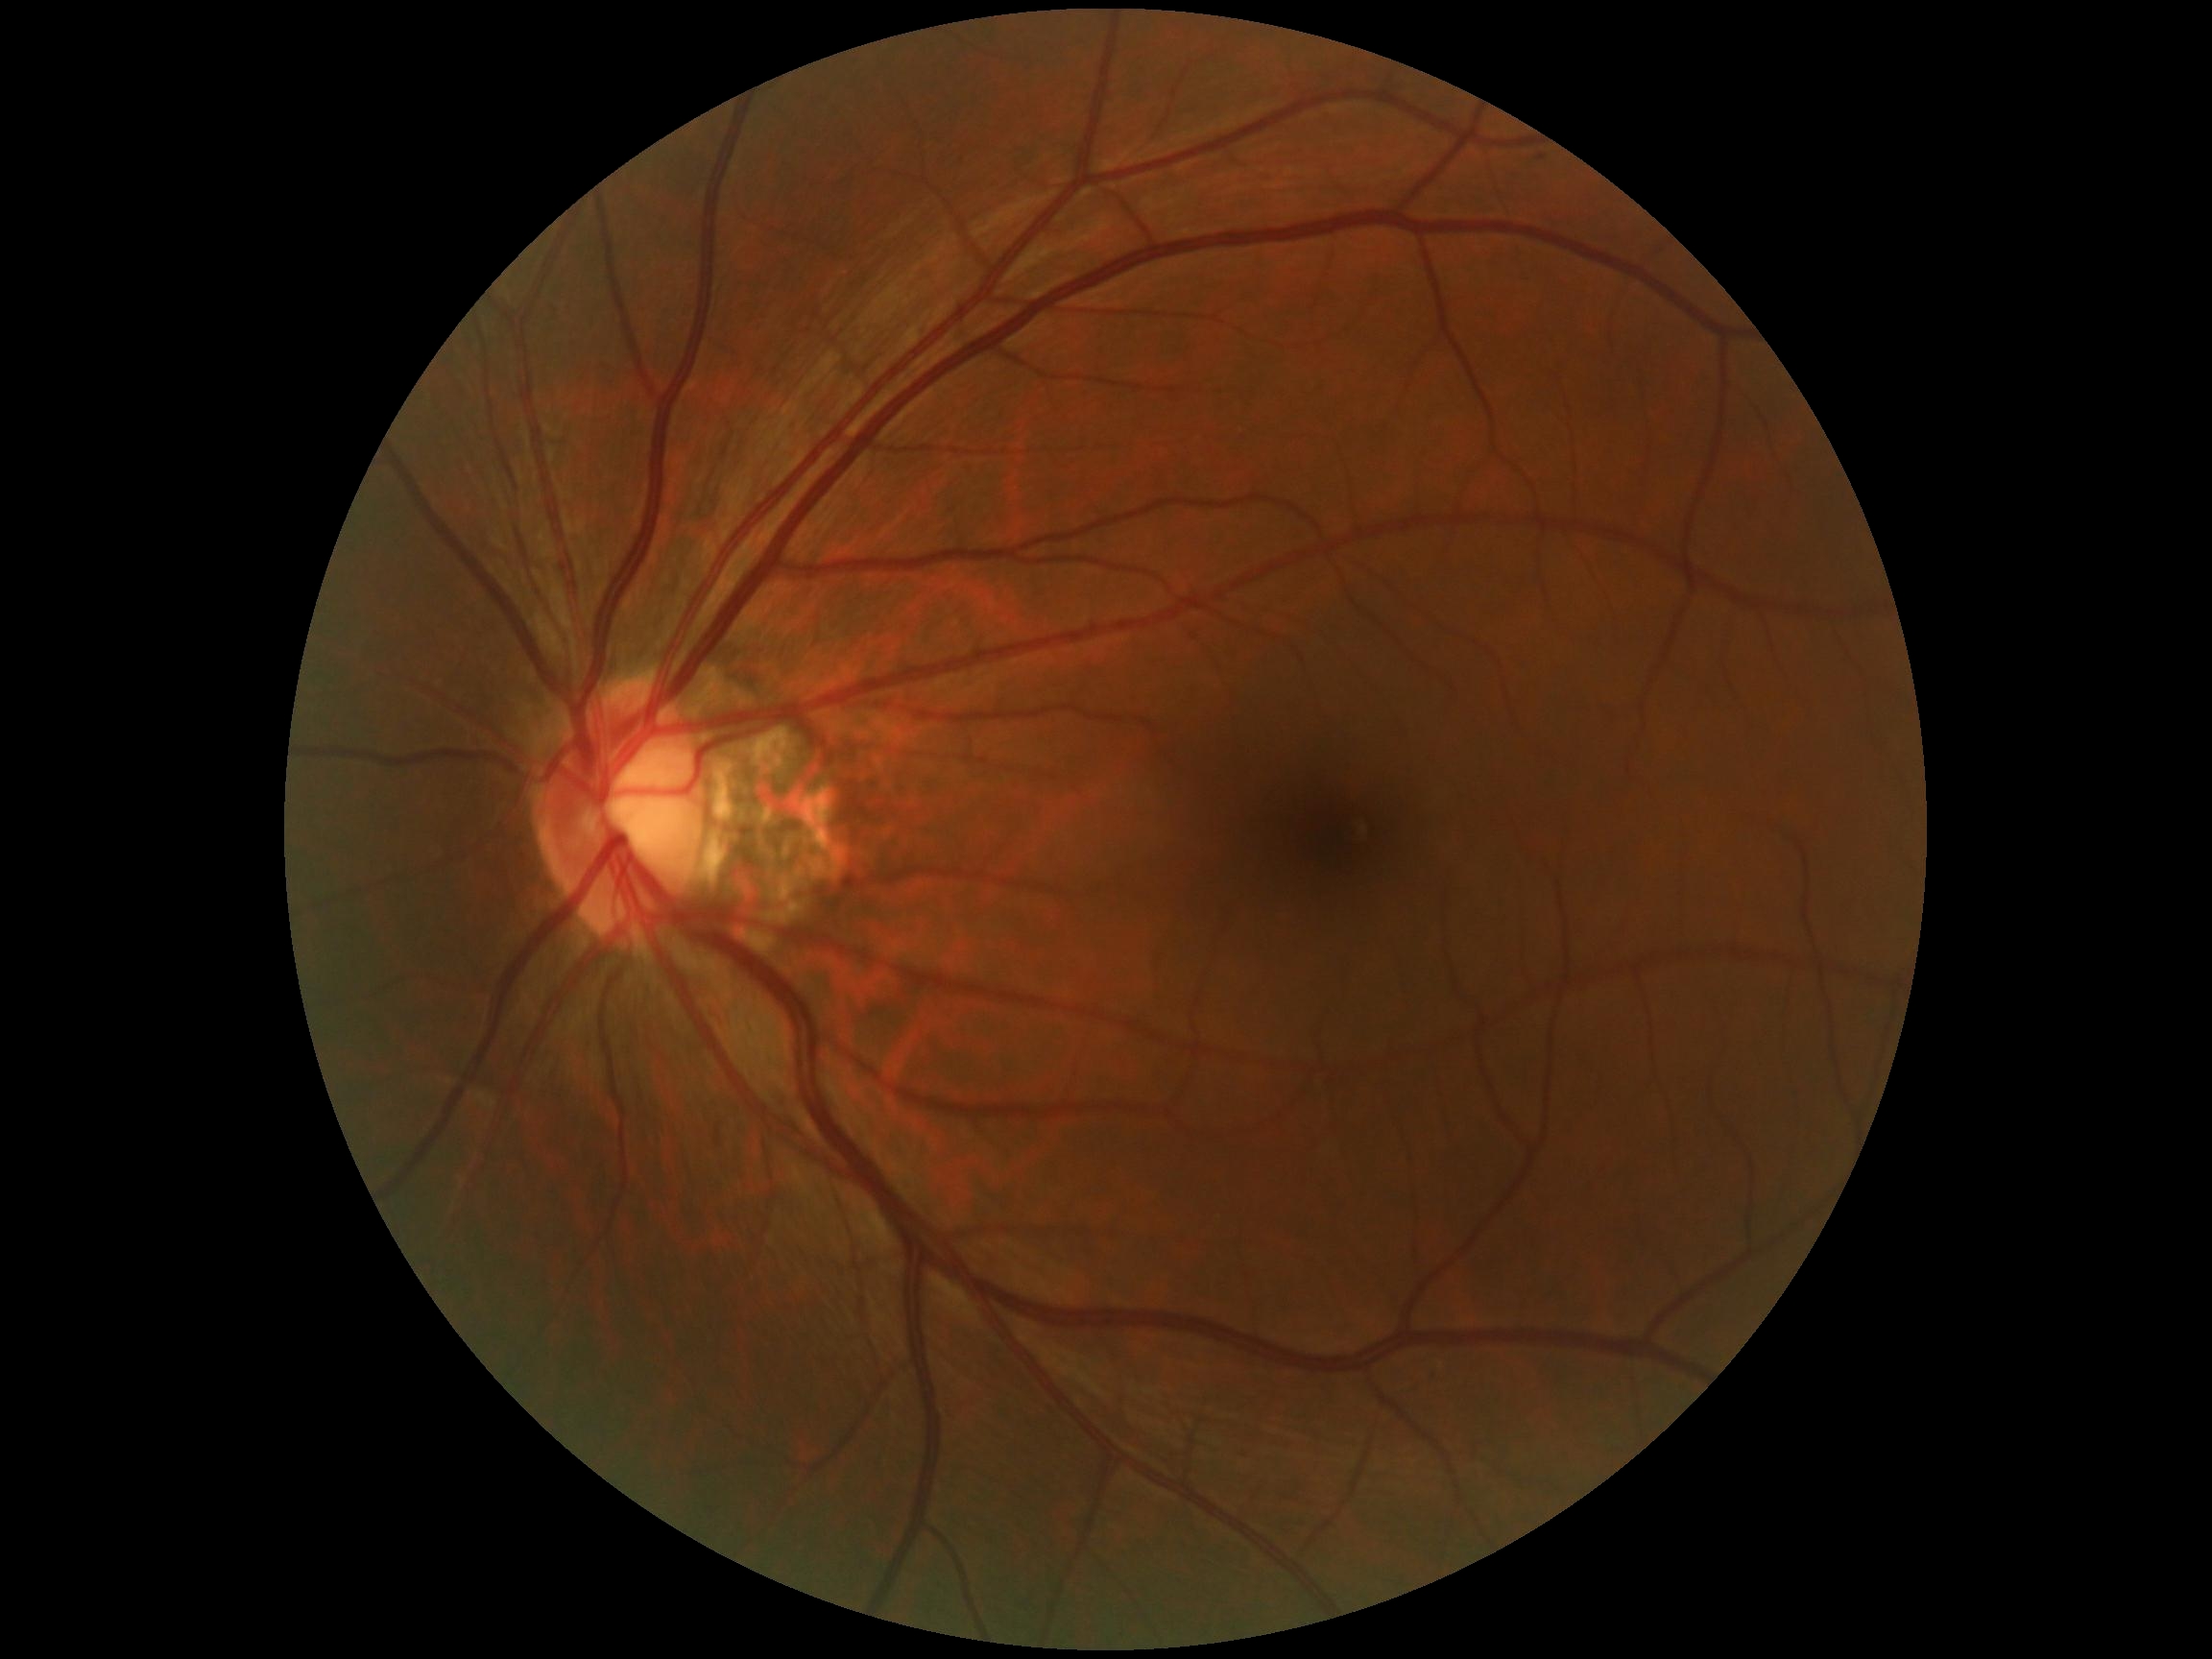
Diabetic retinopathy (DR) is no apparent diabetic retinopathy (grade 0).